Disc-centered field
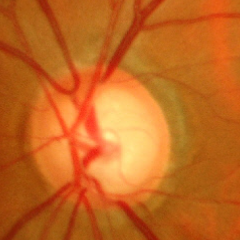

Glaucomatous changes are present. Optic disc photograph demonstrating advanced glaucoma. Defined as near-total cupping of the optic nerve head, with or without severe visual field loss within the central 10 degrees of fixation.